Color fundus photograph, 45-degree field of view, image size 2352x1568: 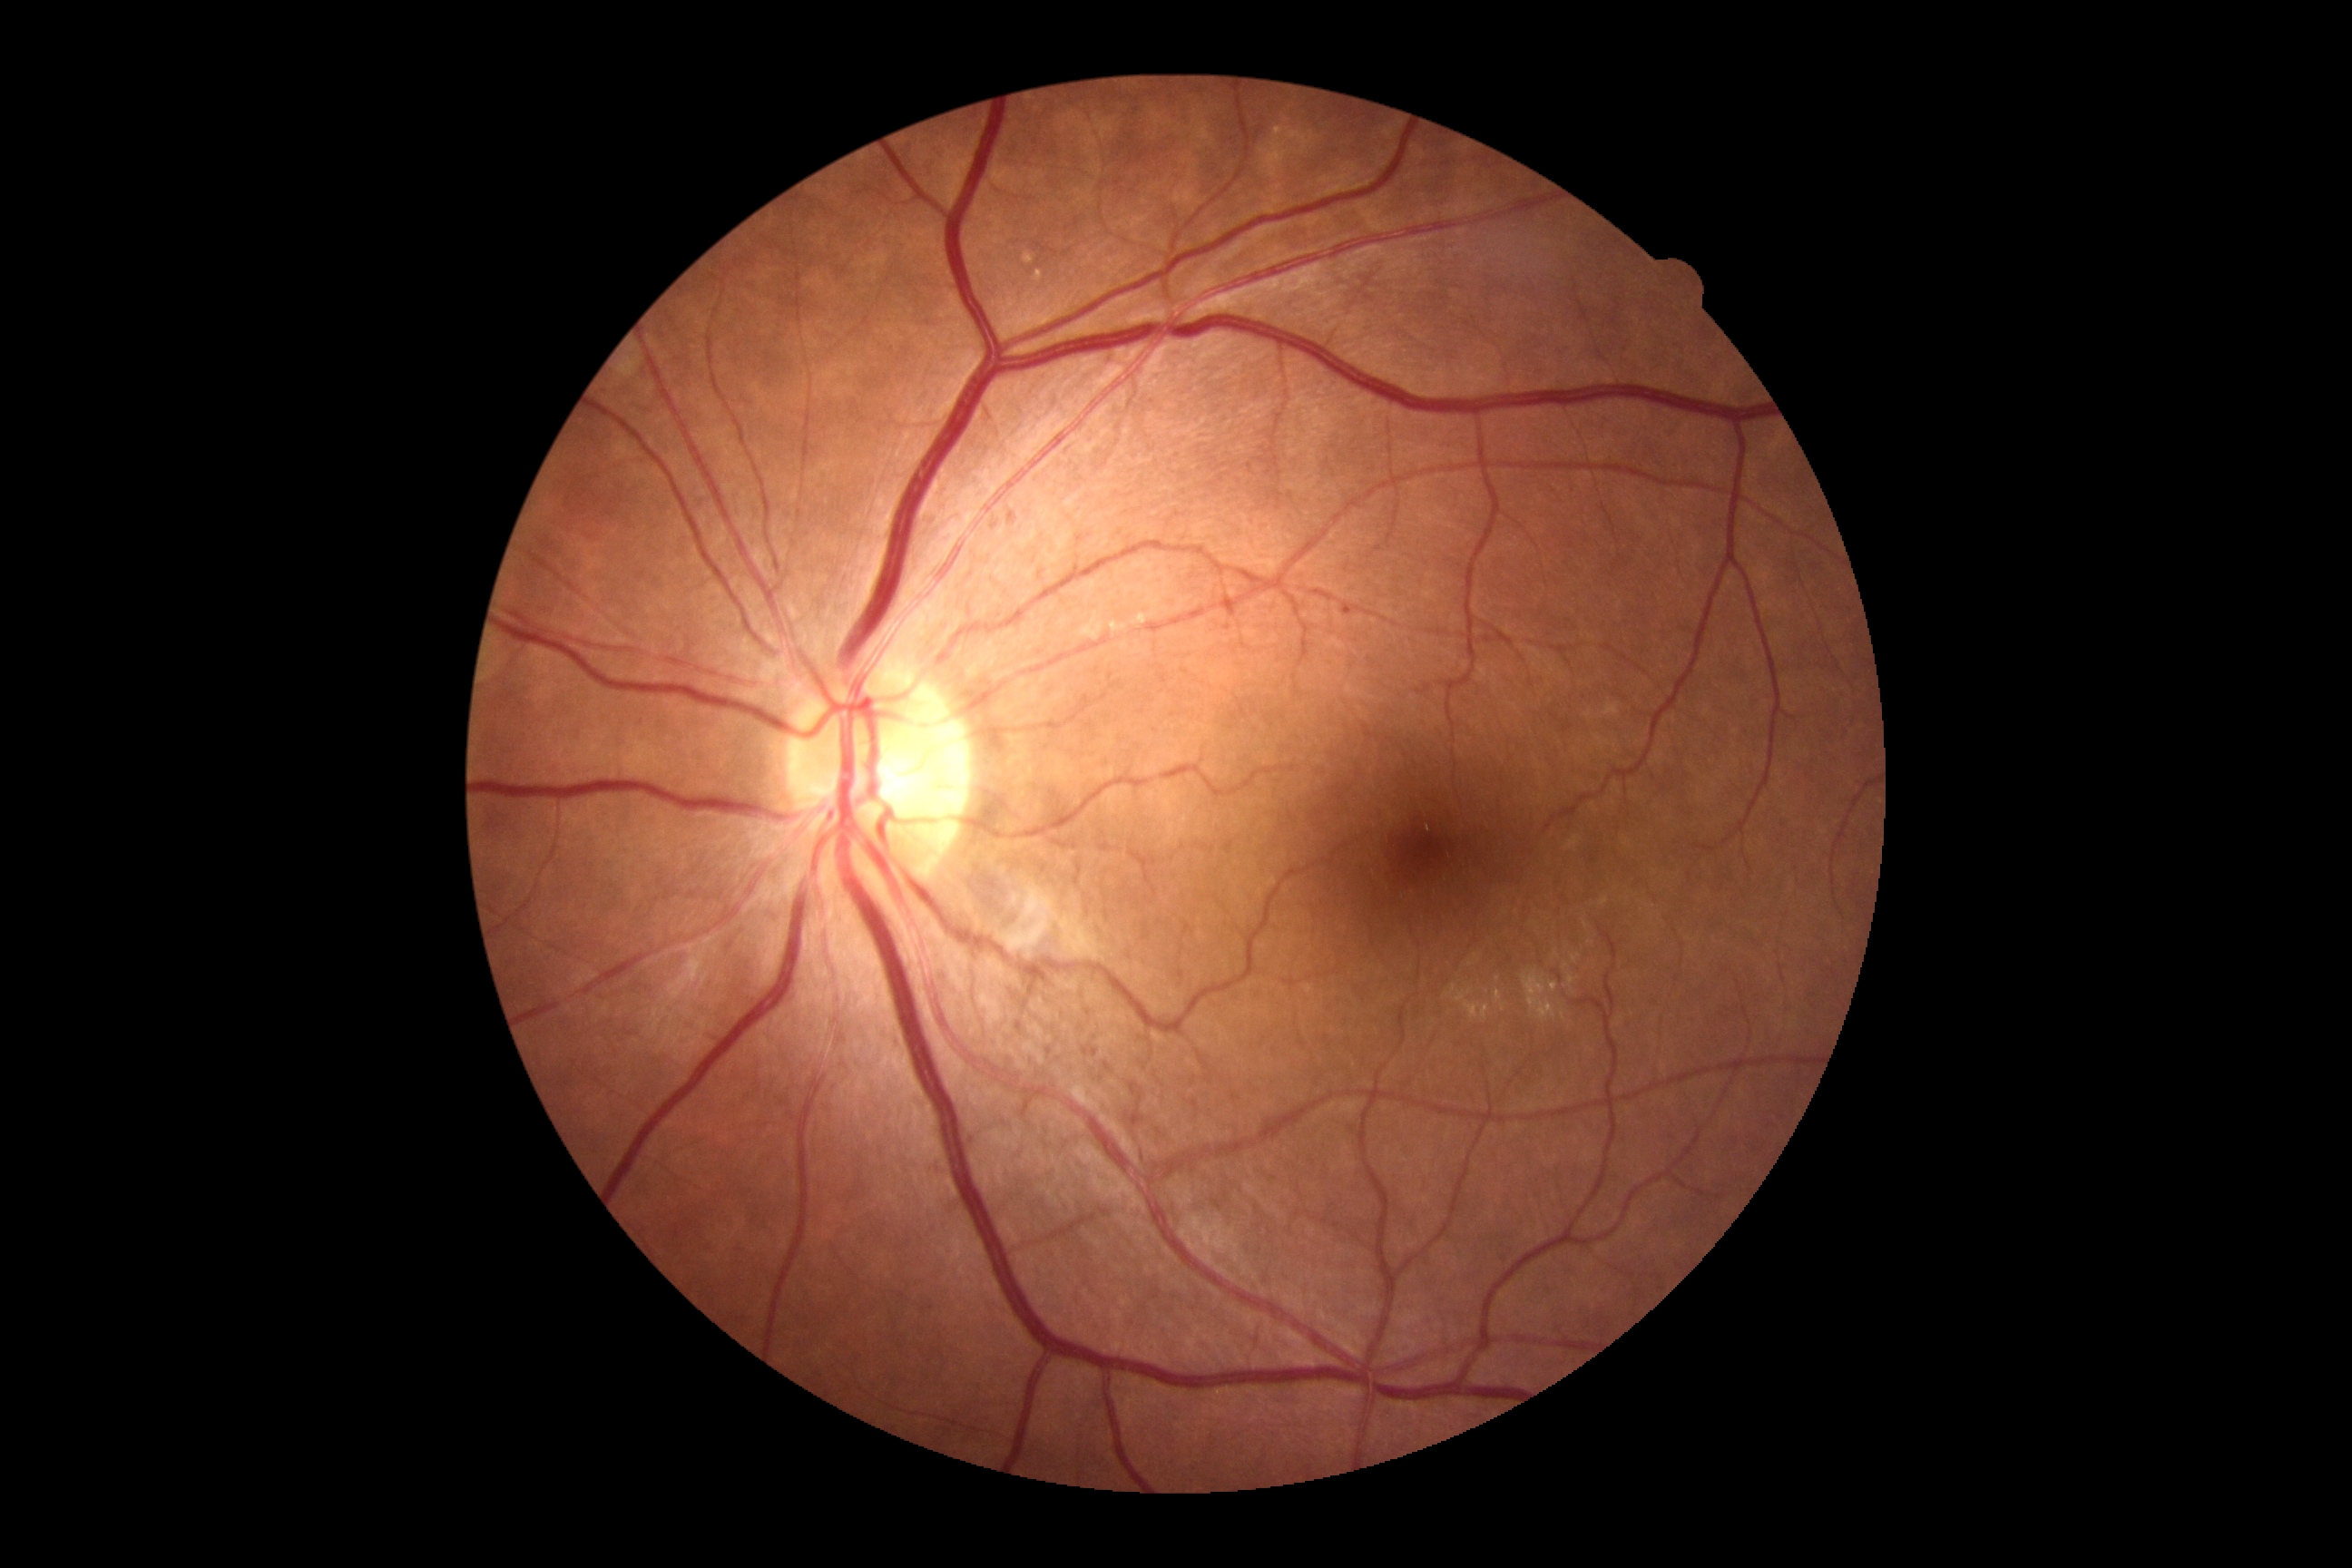 Disease class: non-proliferative diabetic retinopathy. DR stage: 2.